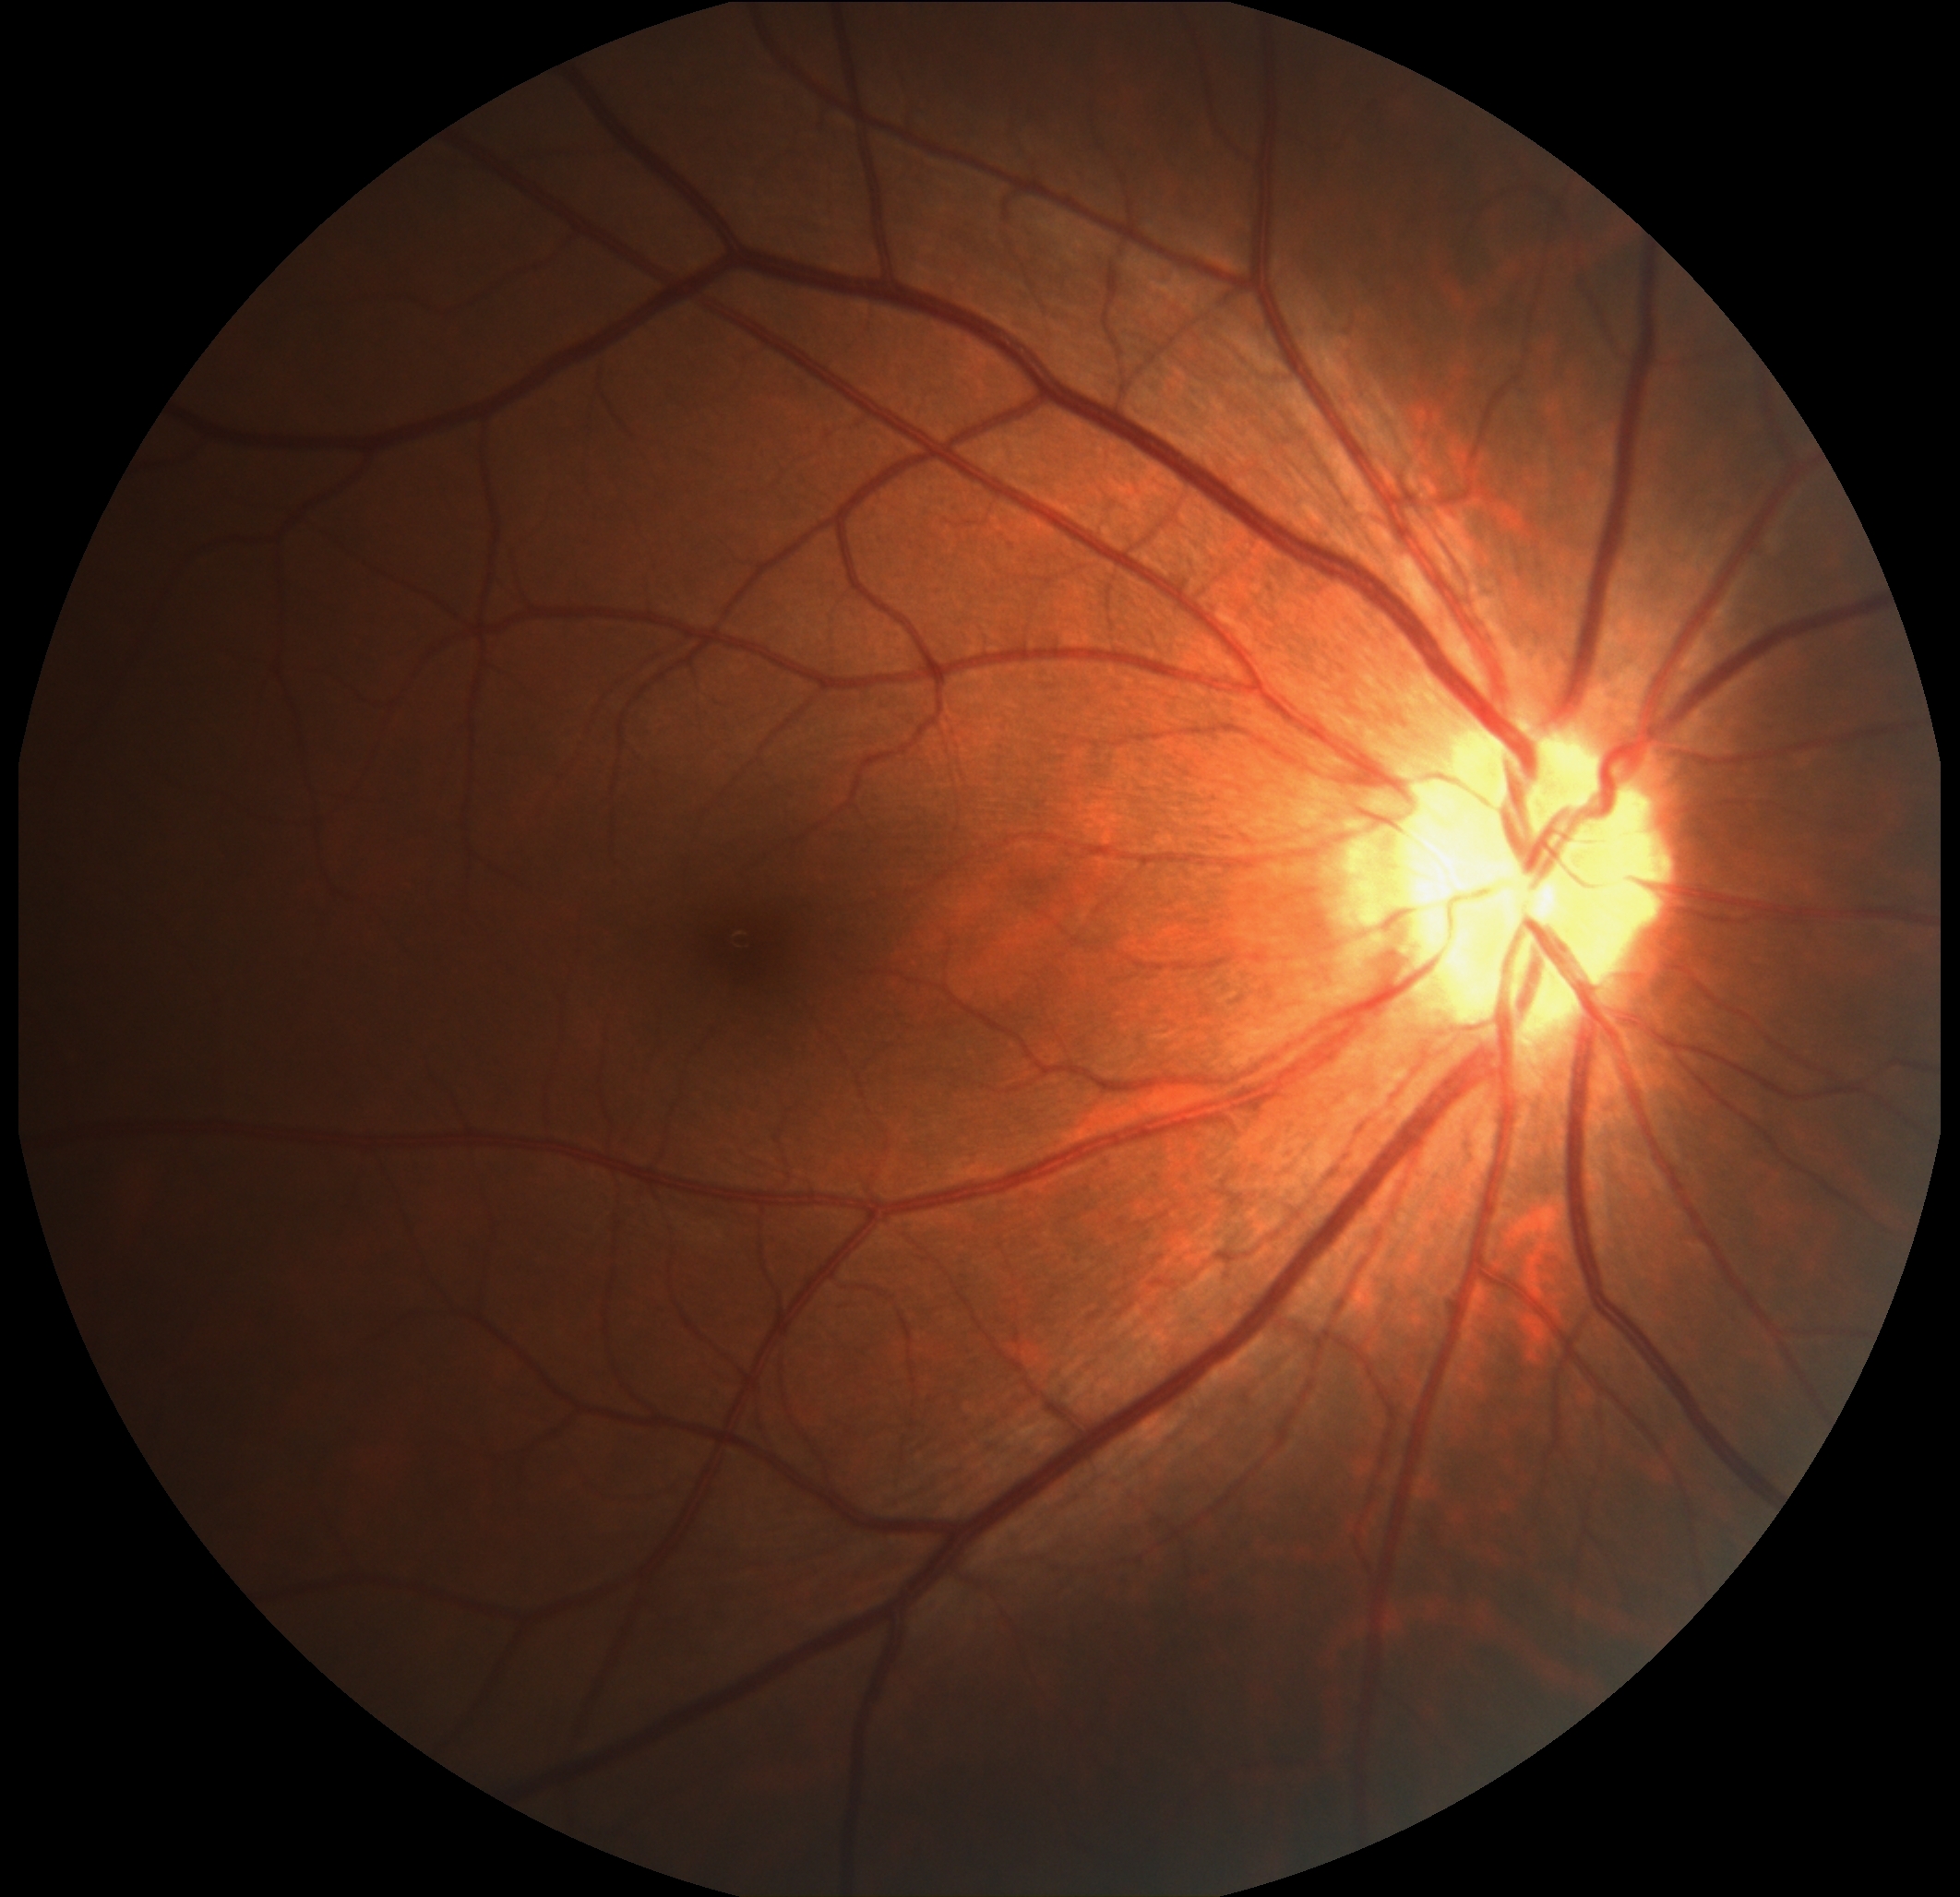

Diabetic retinopathy grade is 0/4.